Fundus photo, 1380 x 1382 pixels — 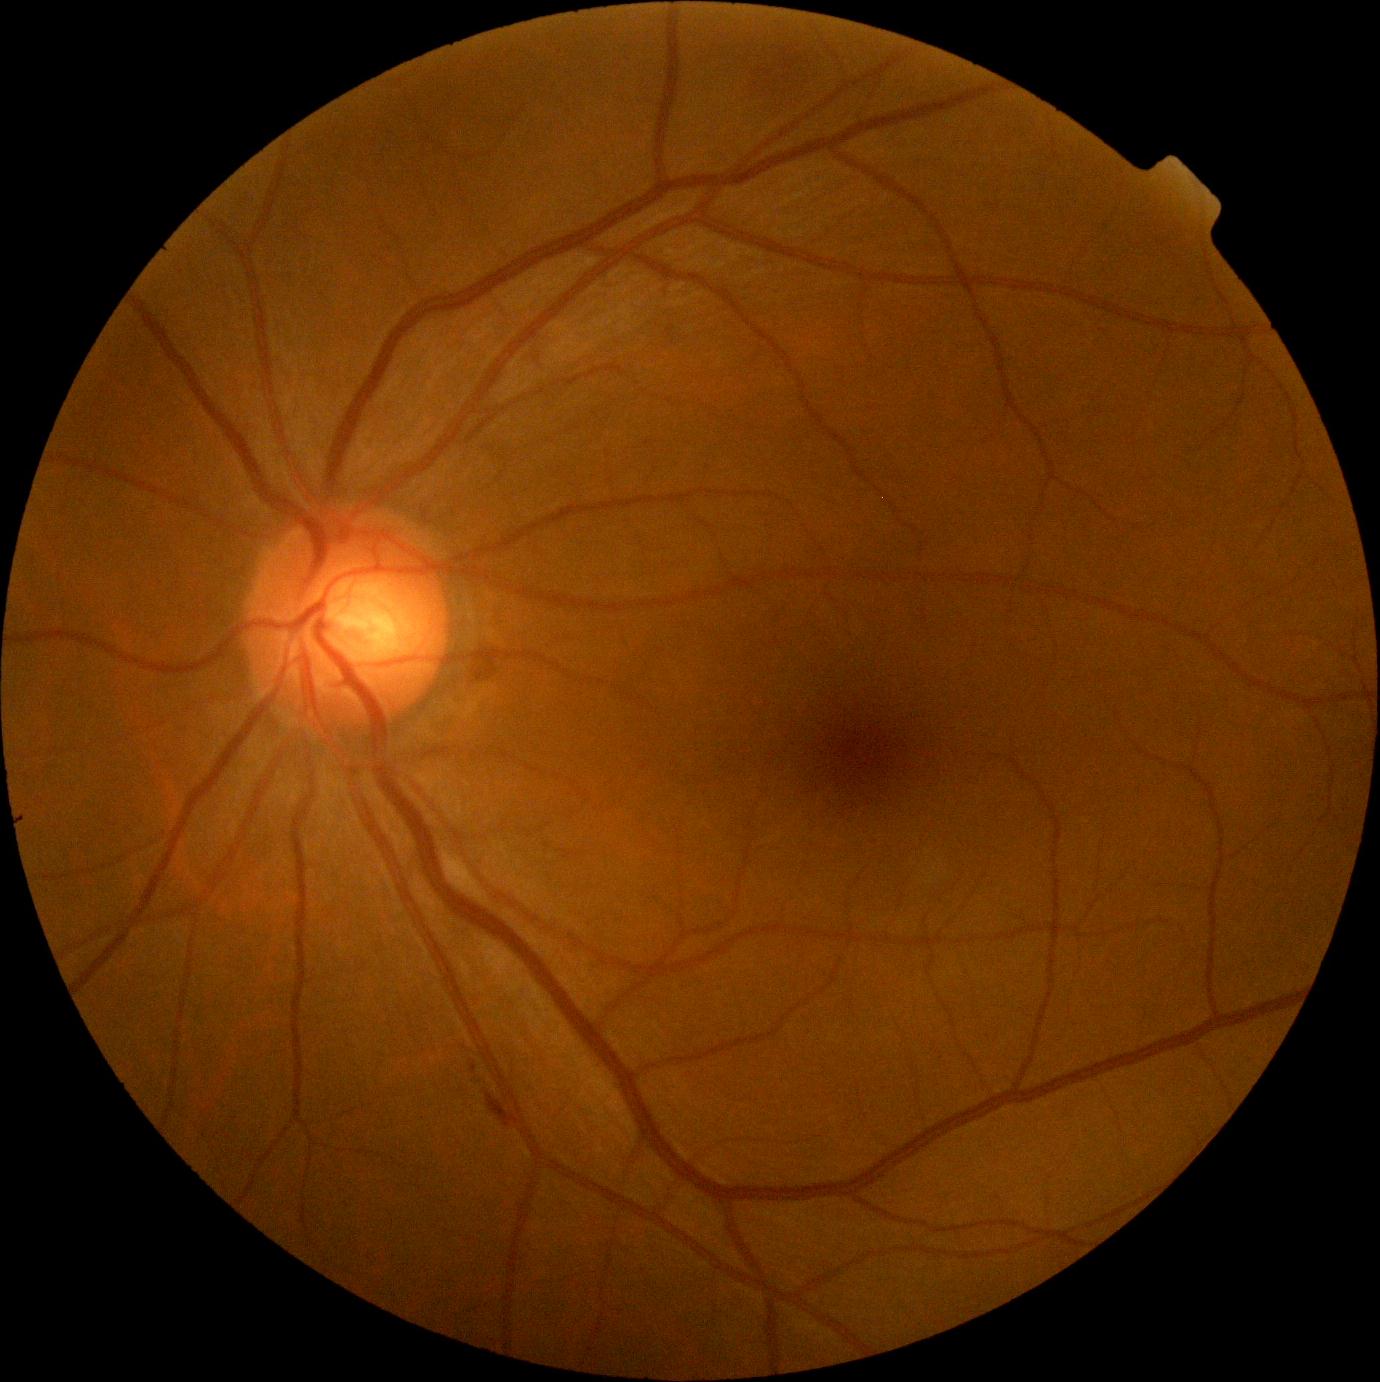

DR grade is moderate NPDR (2). Disease class: non-proliferative diabetic retinopathy.